2352x1568
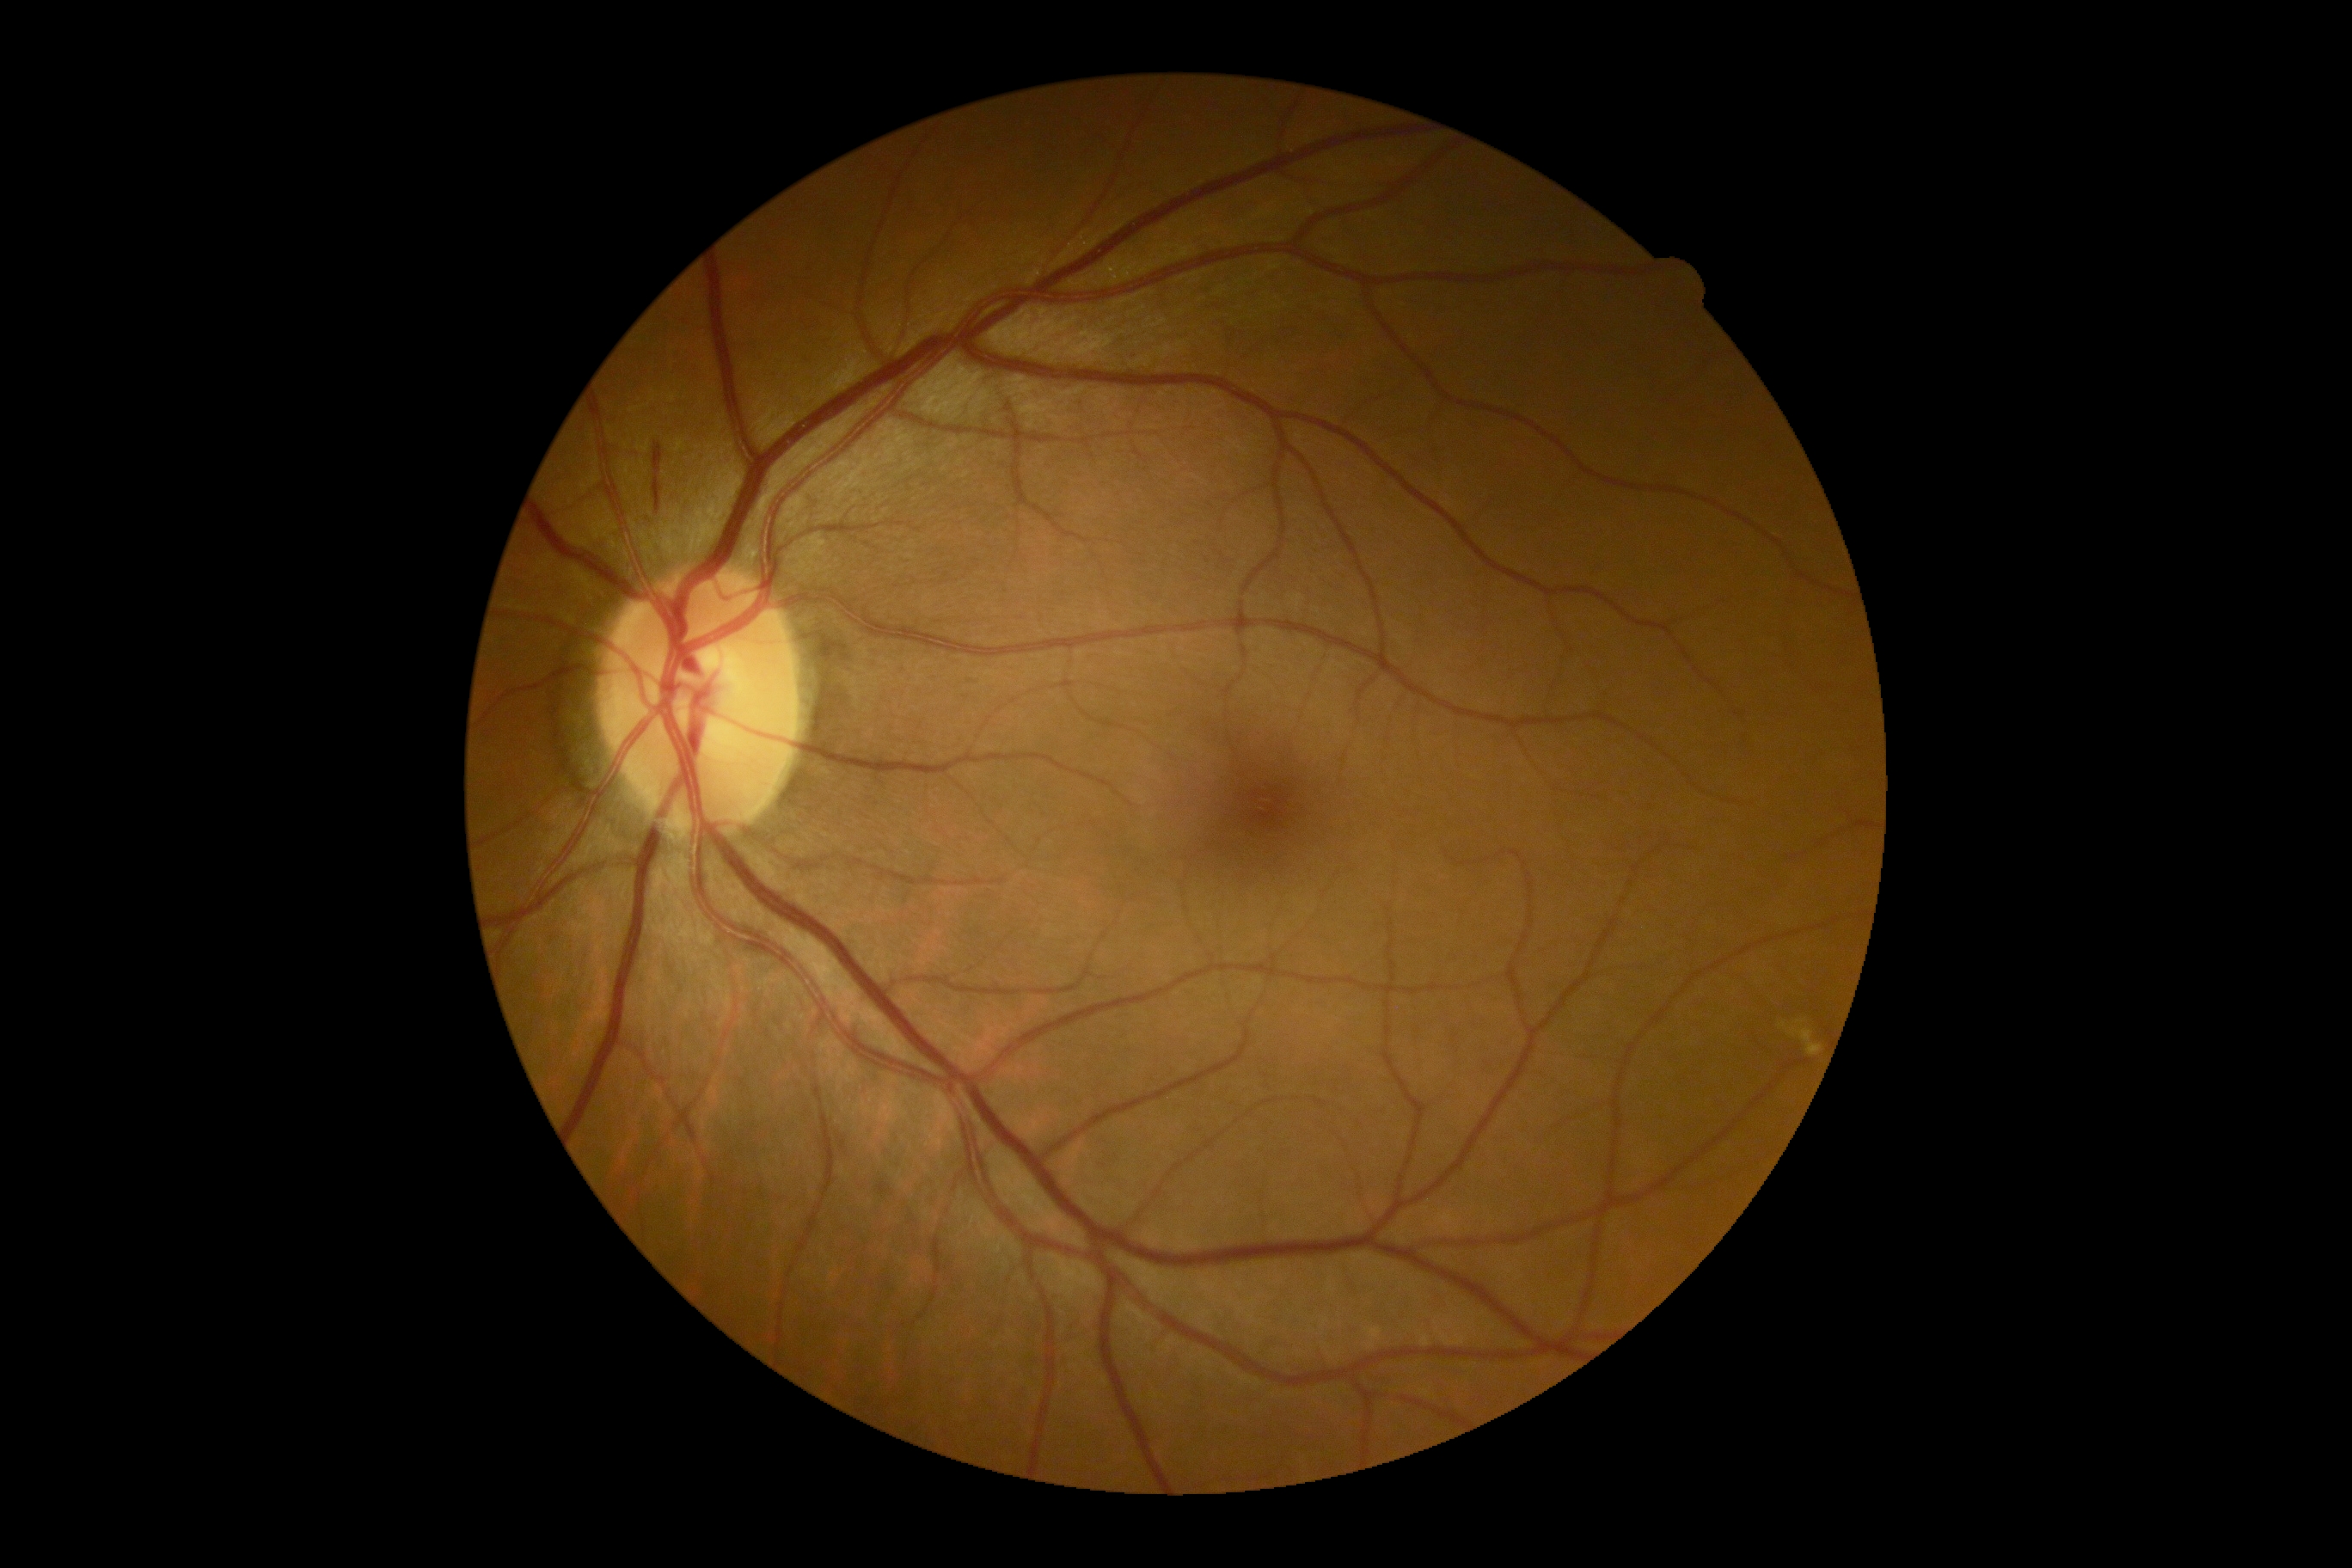 Findings:
* DR class — non-proliferative diabetic retinopathy
* DR — 2